Nonmydriatic · DR severity per modified Davis staging: 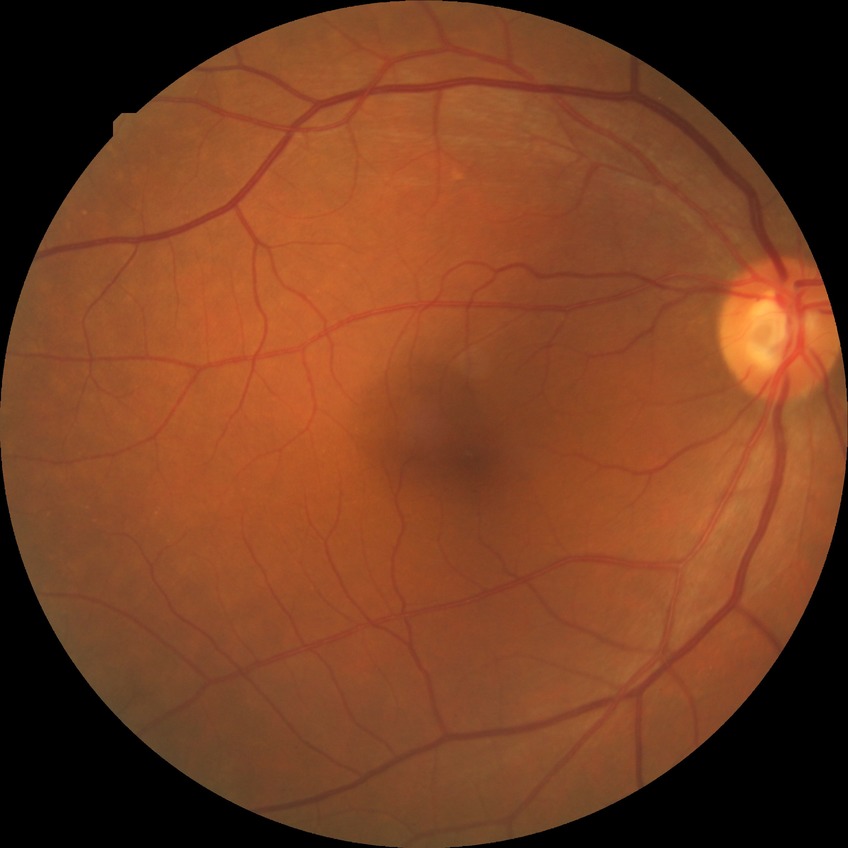

Davis grade is NDR.